848x848px, acquired with a NIDEK AFC-230, no pharmacologic dilation: 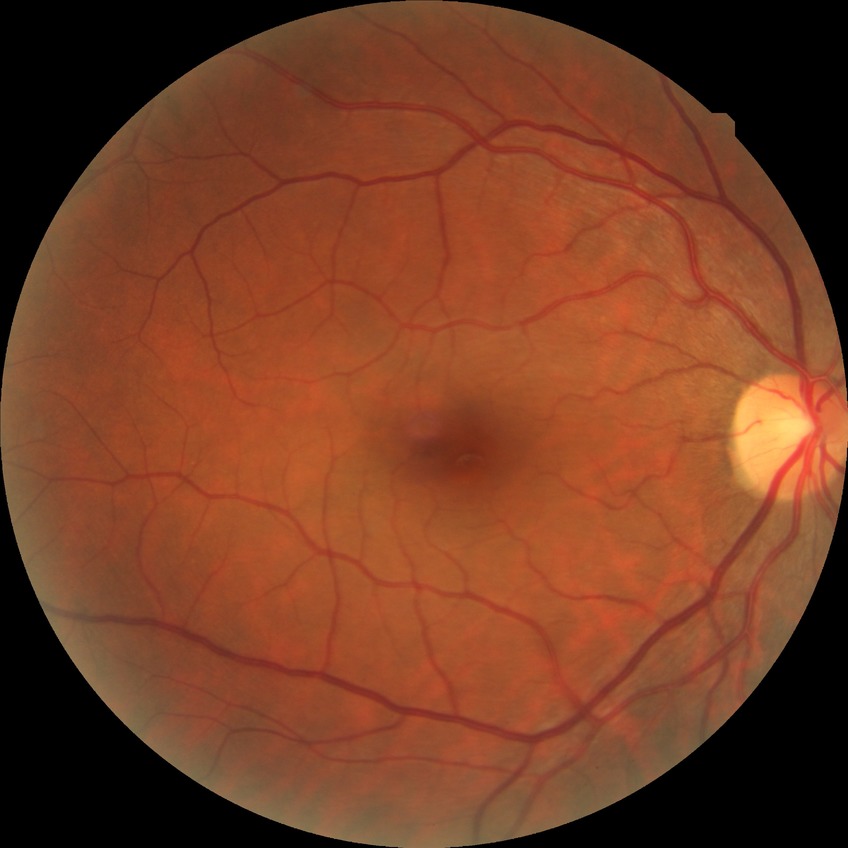
Diabetic retinopathy (DR): NDR (no diabetic retinopathy).